Retinal fundus photograph. 2352x1568. 45-degree field of view: 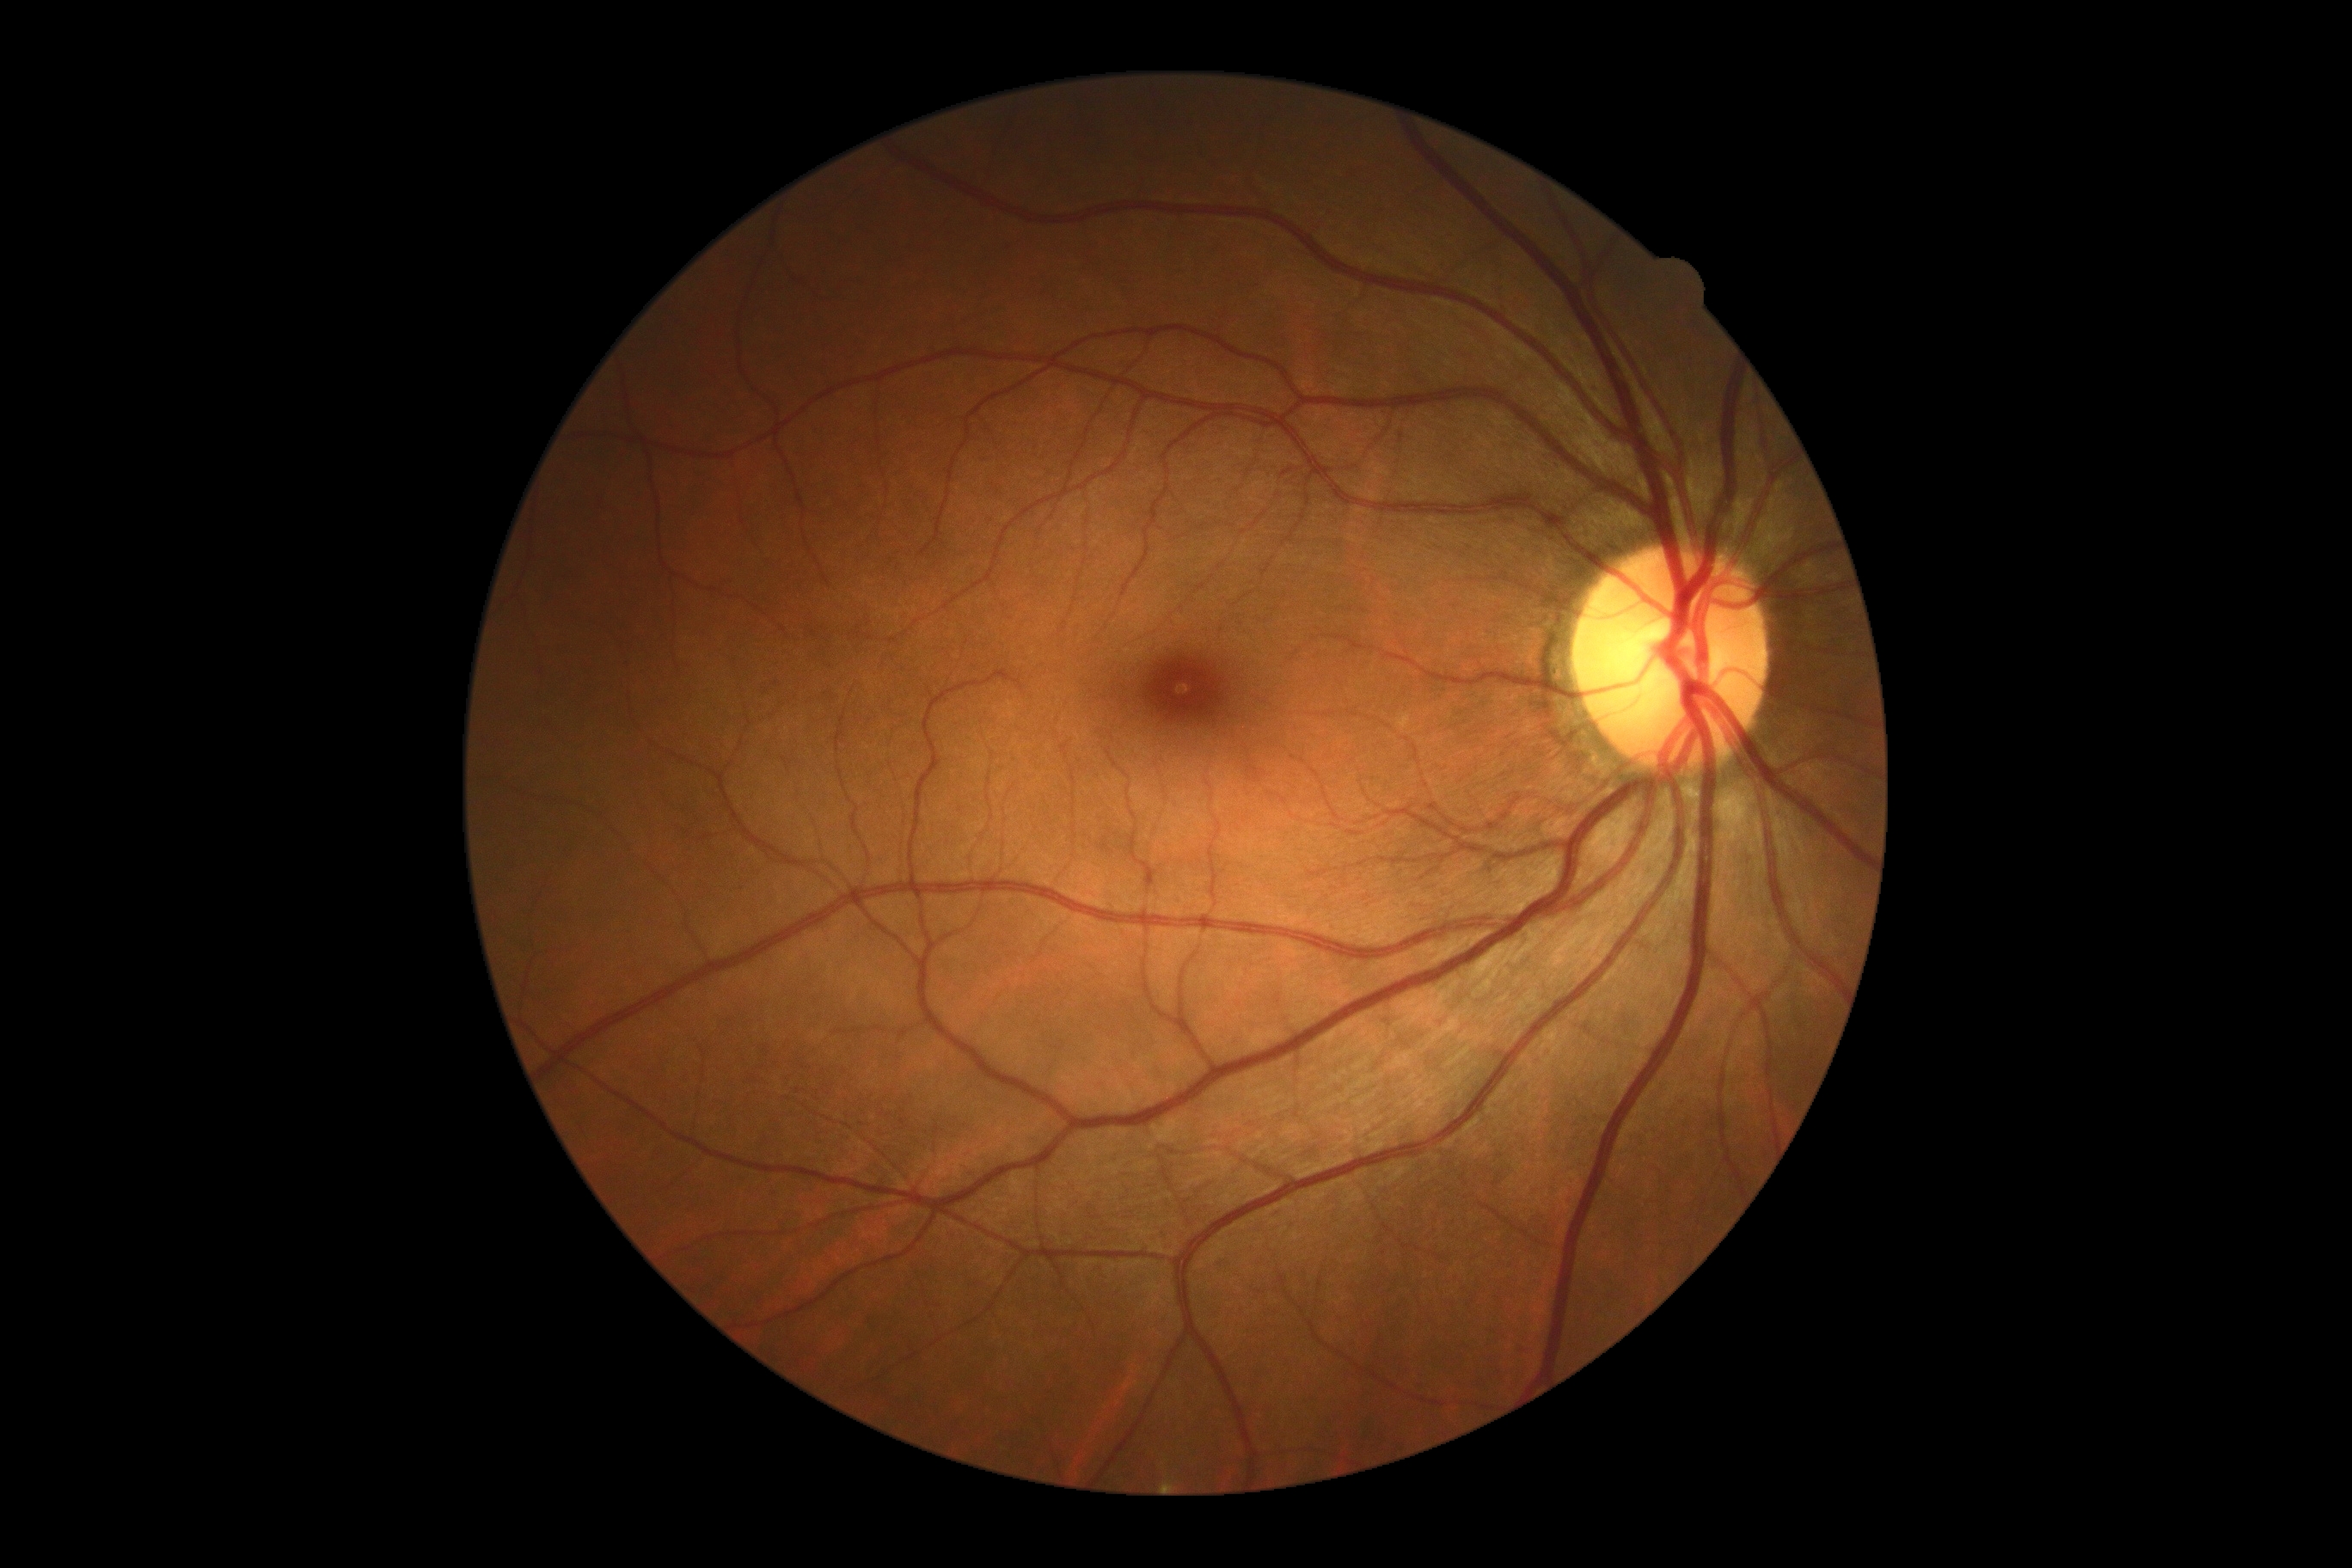 Findings:
* DR impression: no signs of DR
* diabetic retinopathy grade: 0 (no apparent retinopathy)